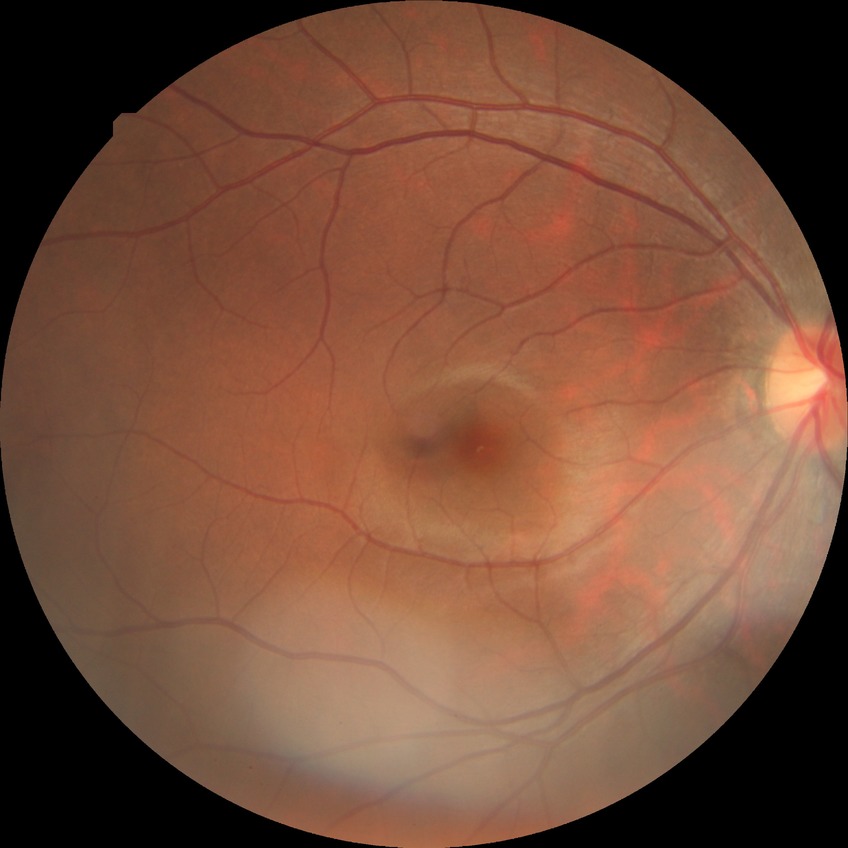
Diabetic retinopathy (DR): NDR (no diabetic retinopathy).